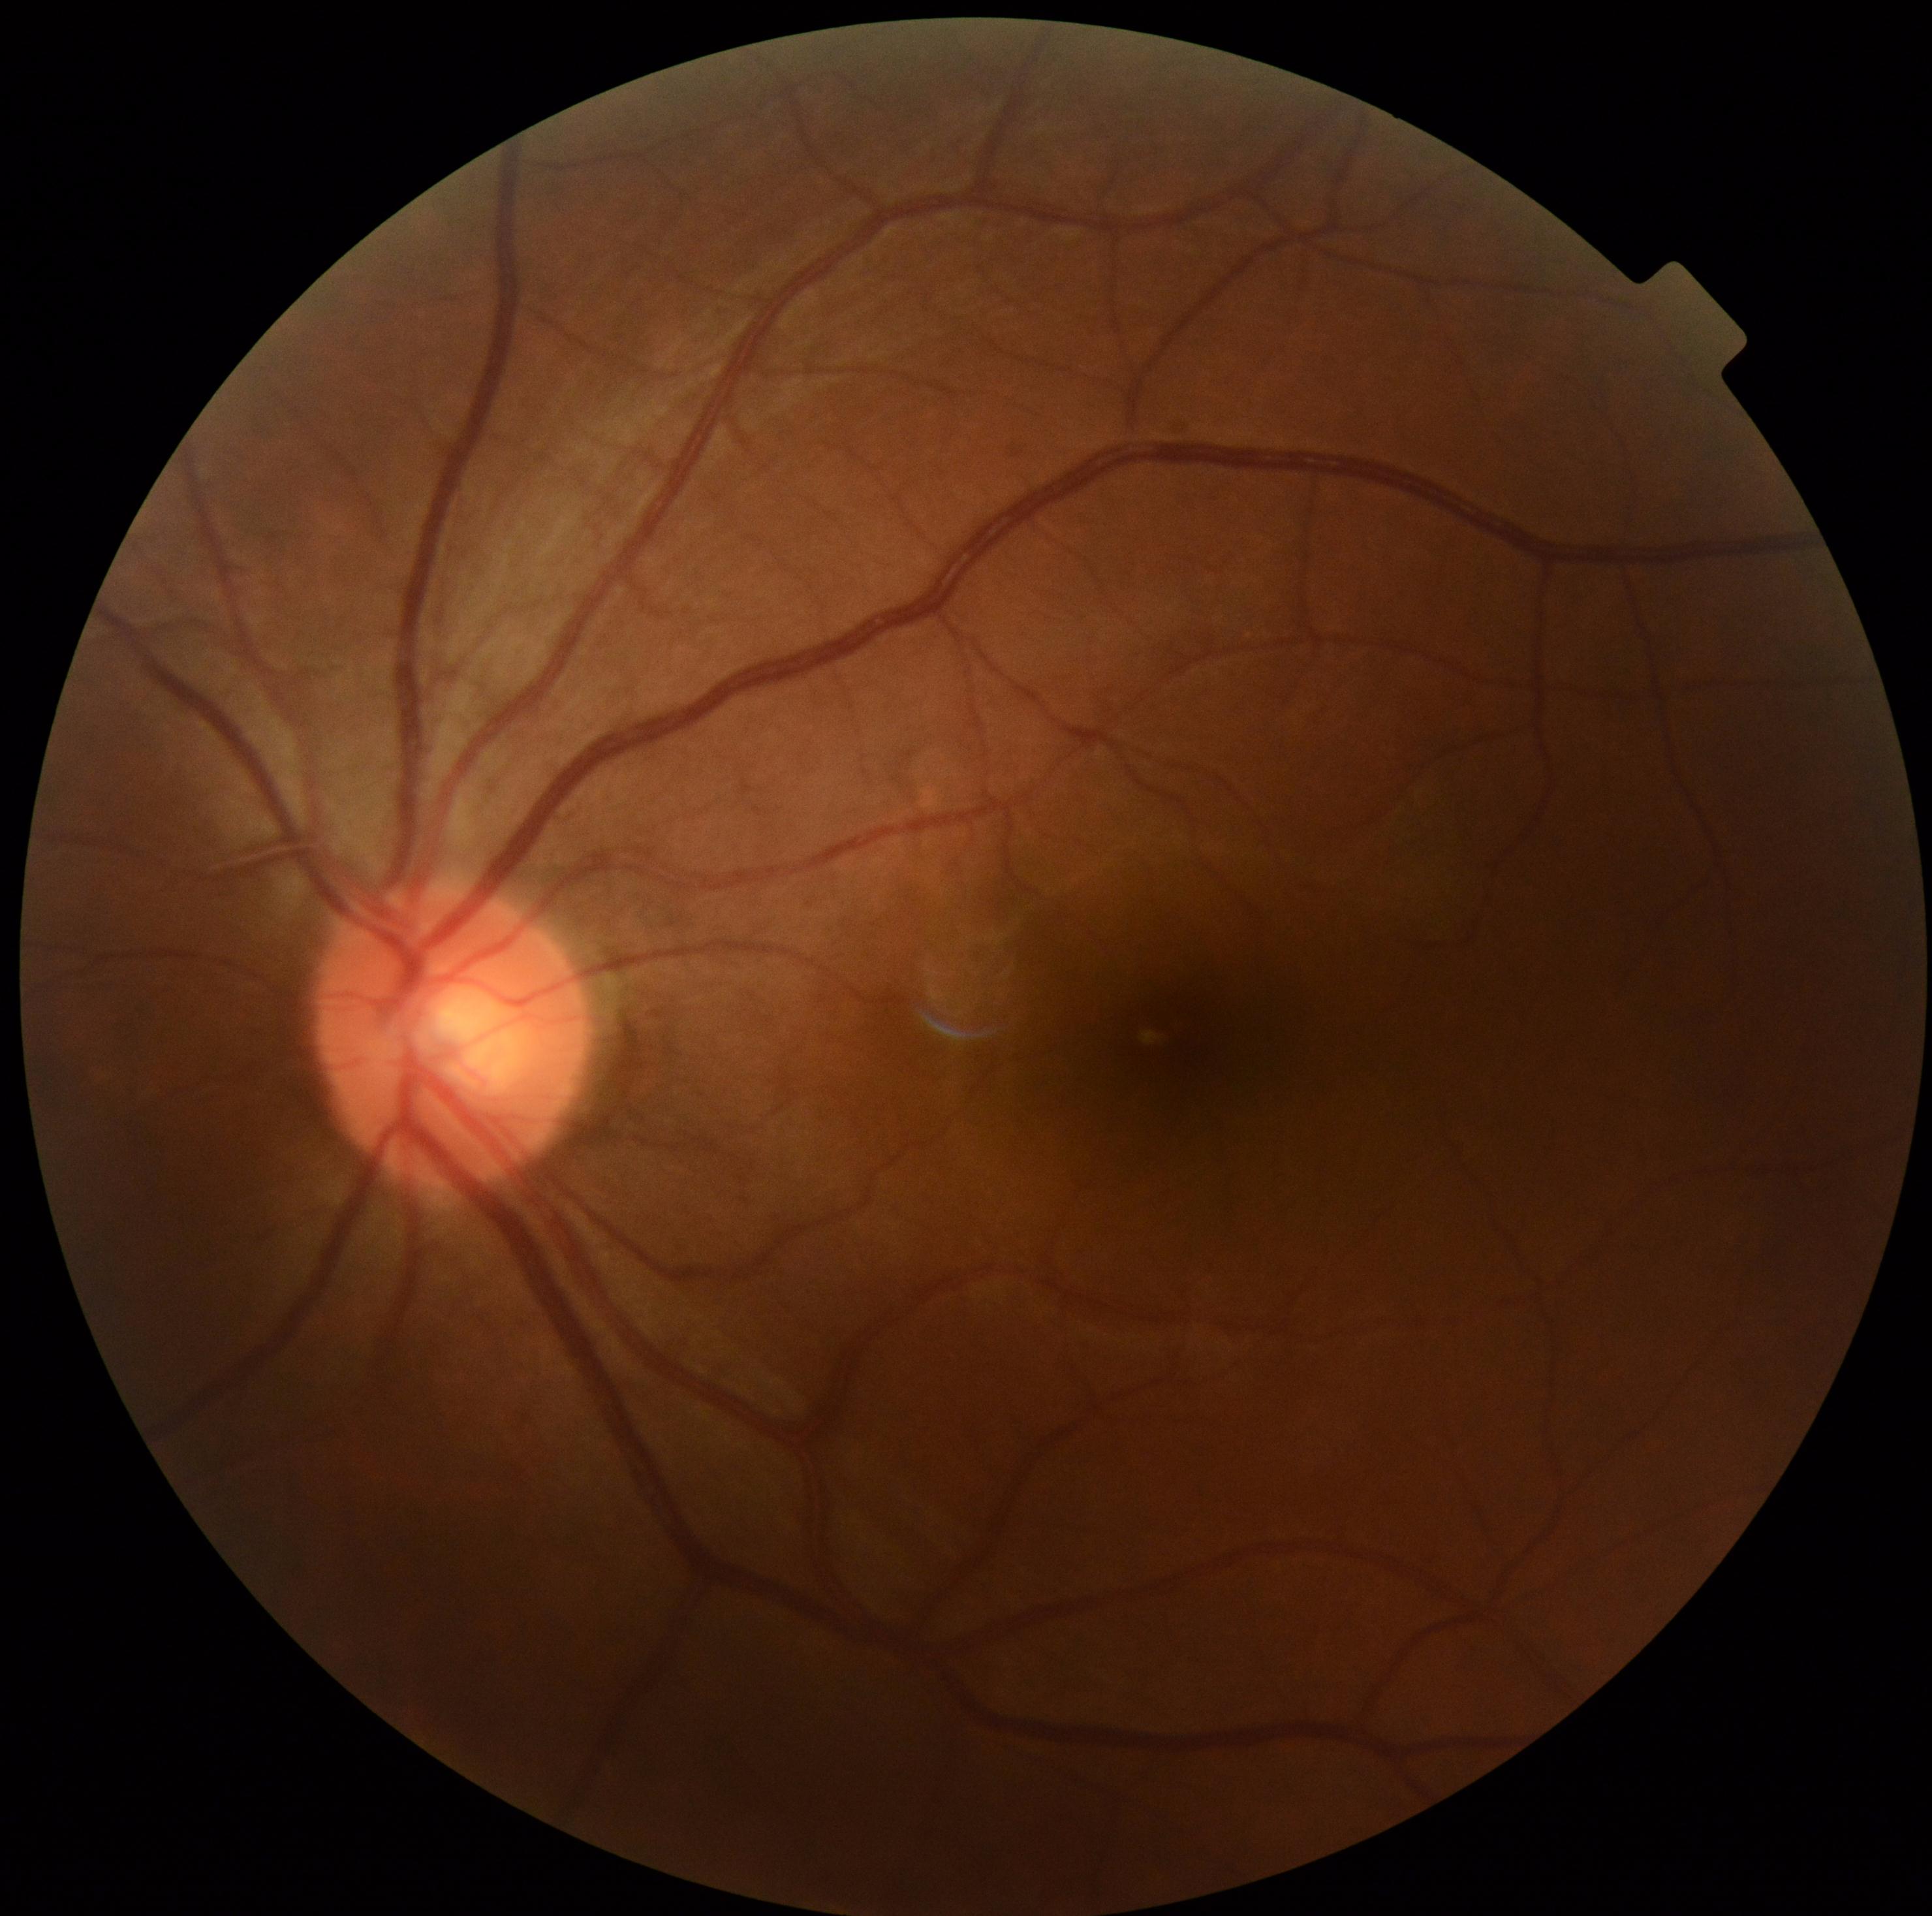

dr_grade: grade 0